Fundus photo:
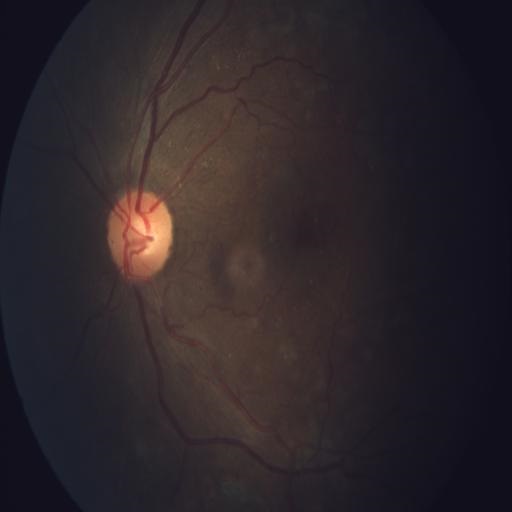

Diagnosis: tortuous vessels (TV).